45° FOV: 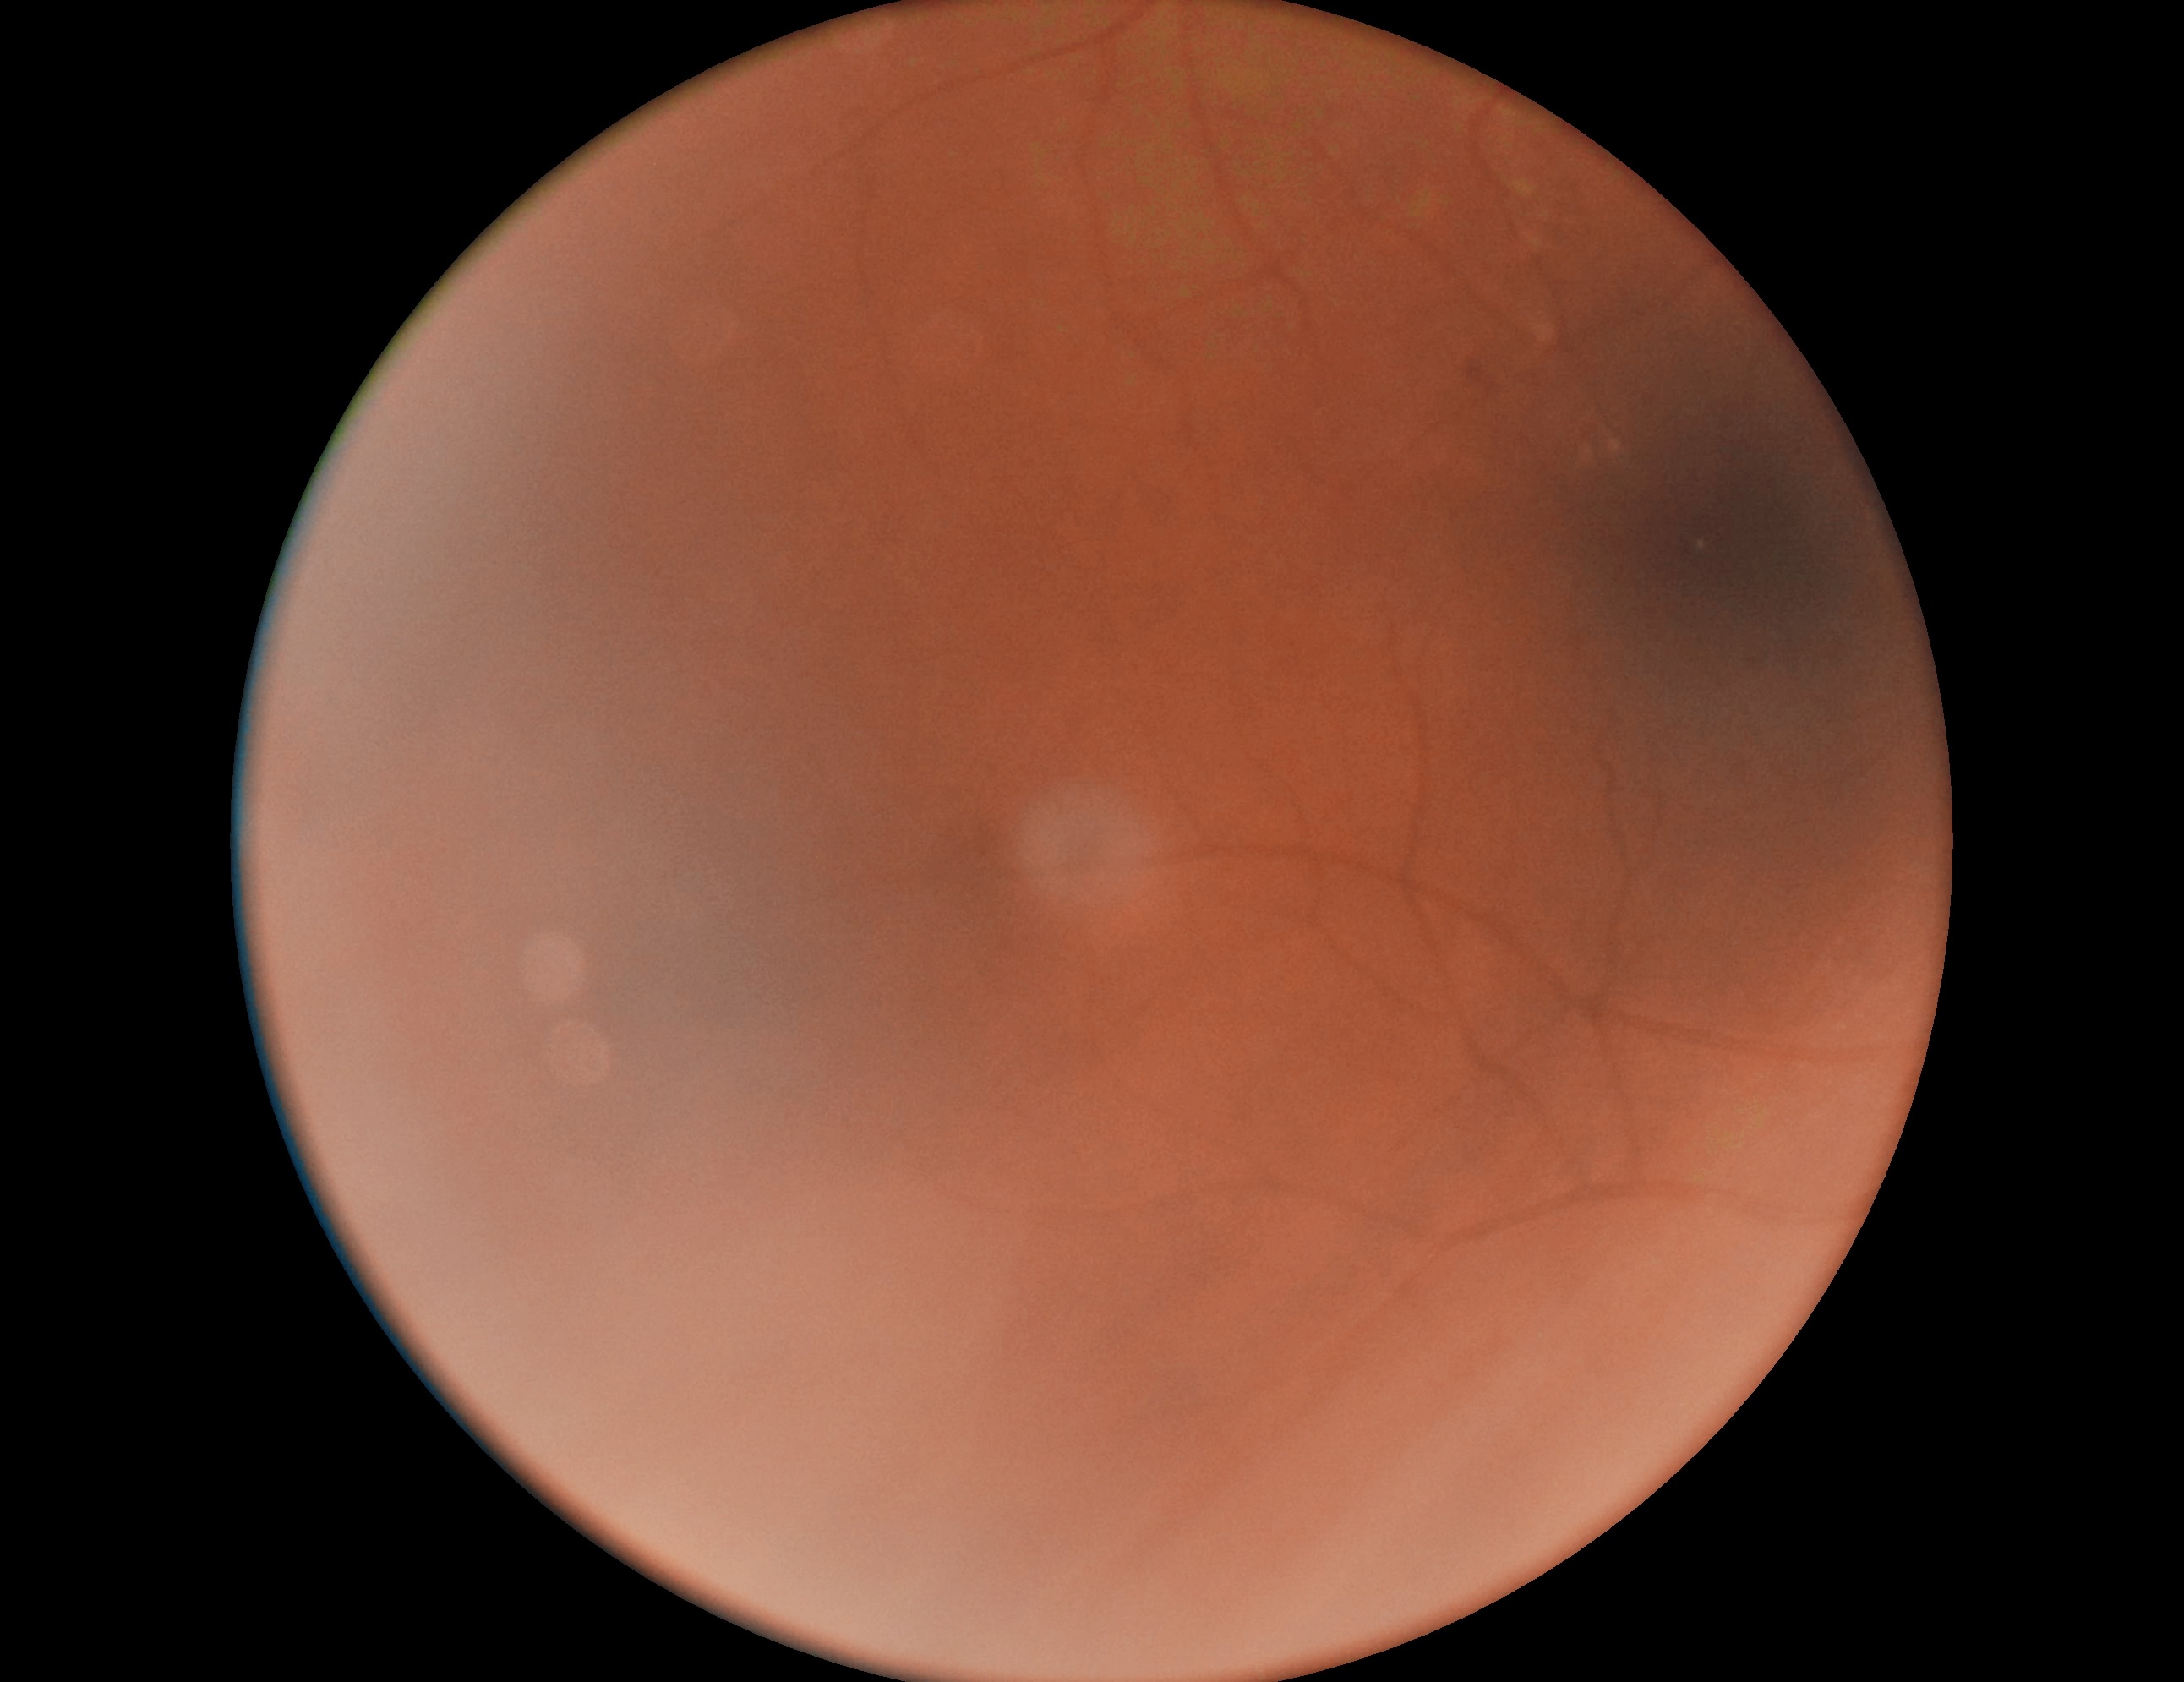
DR stage@moderate non-proliferative diabetic retinopathy (grade 2).